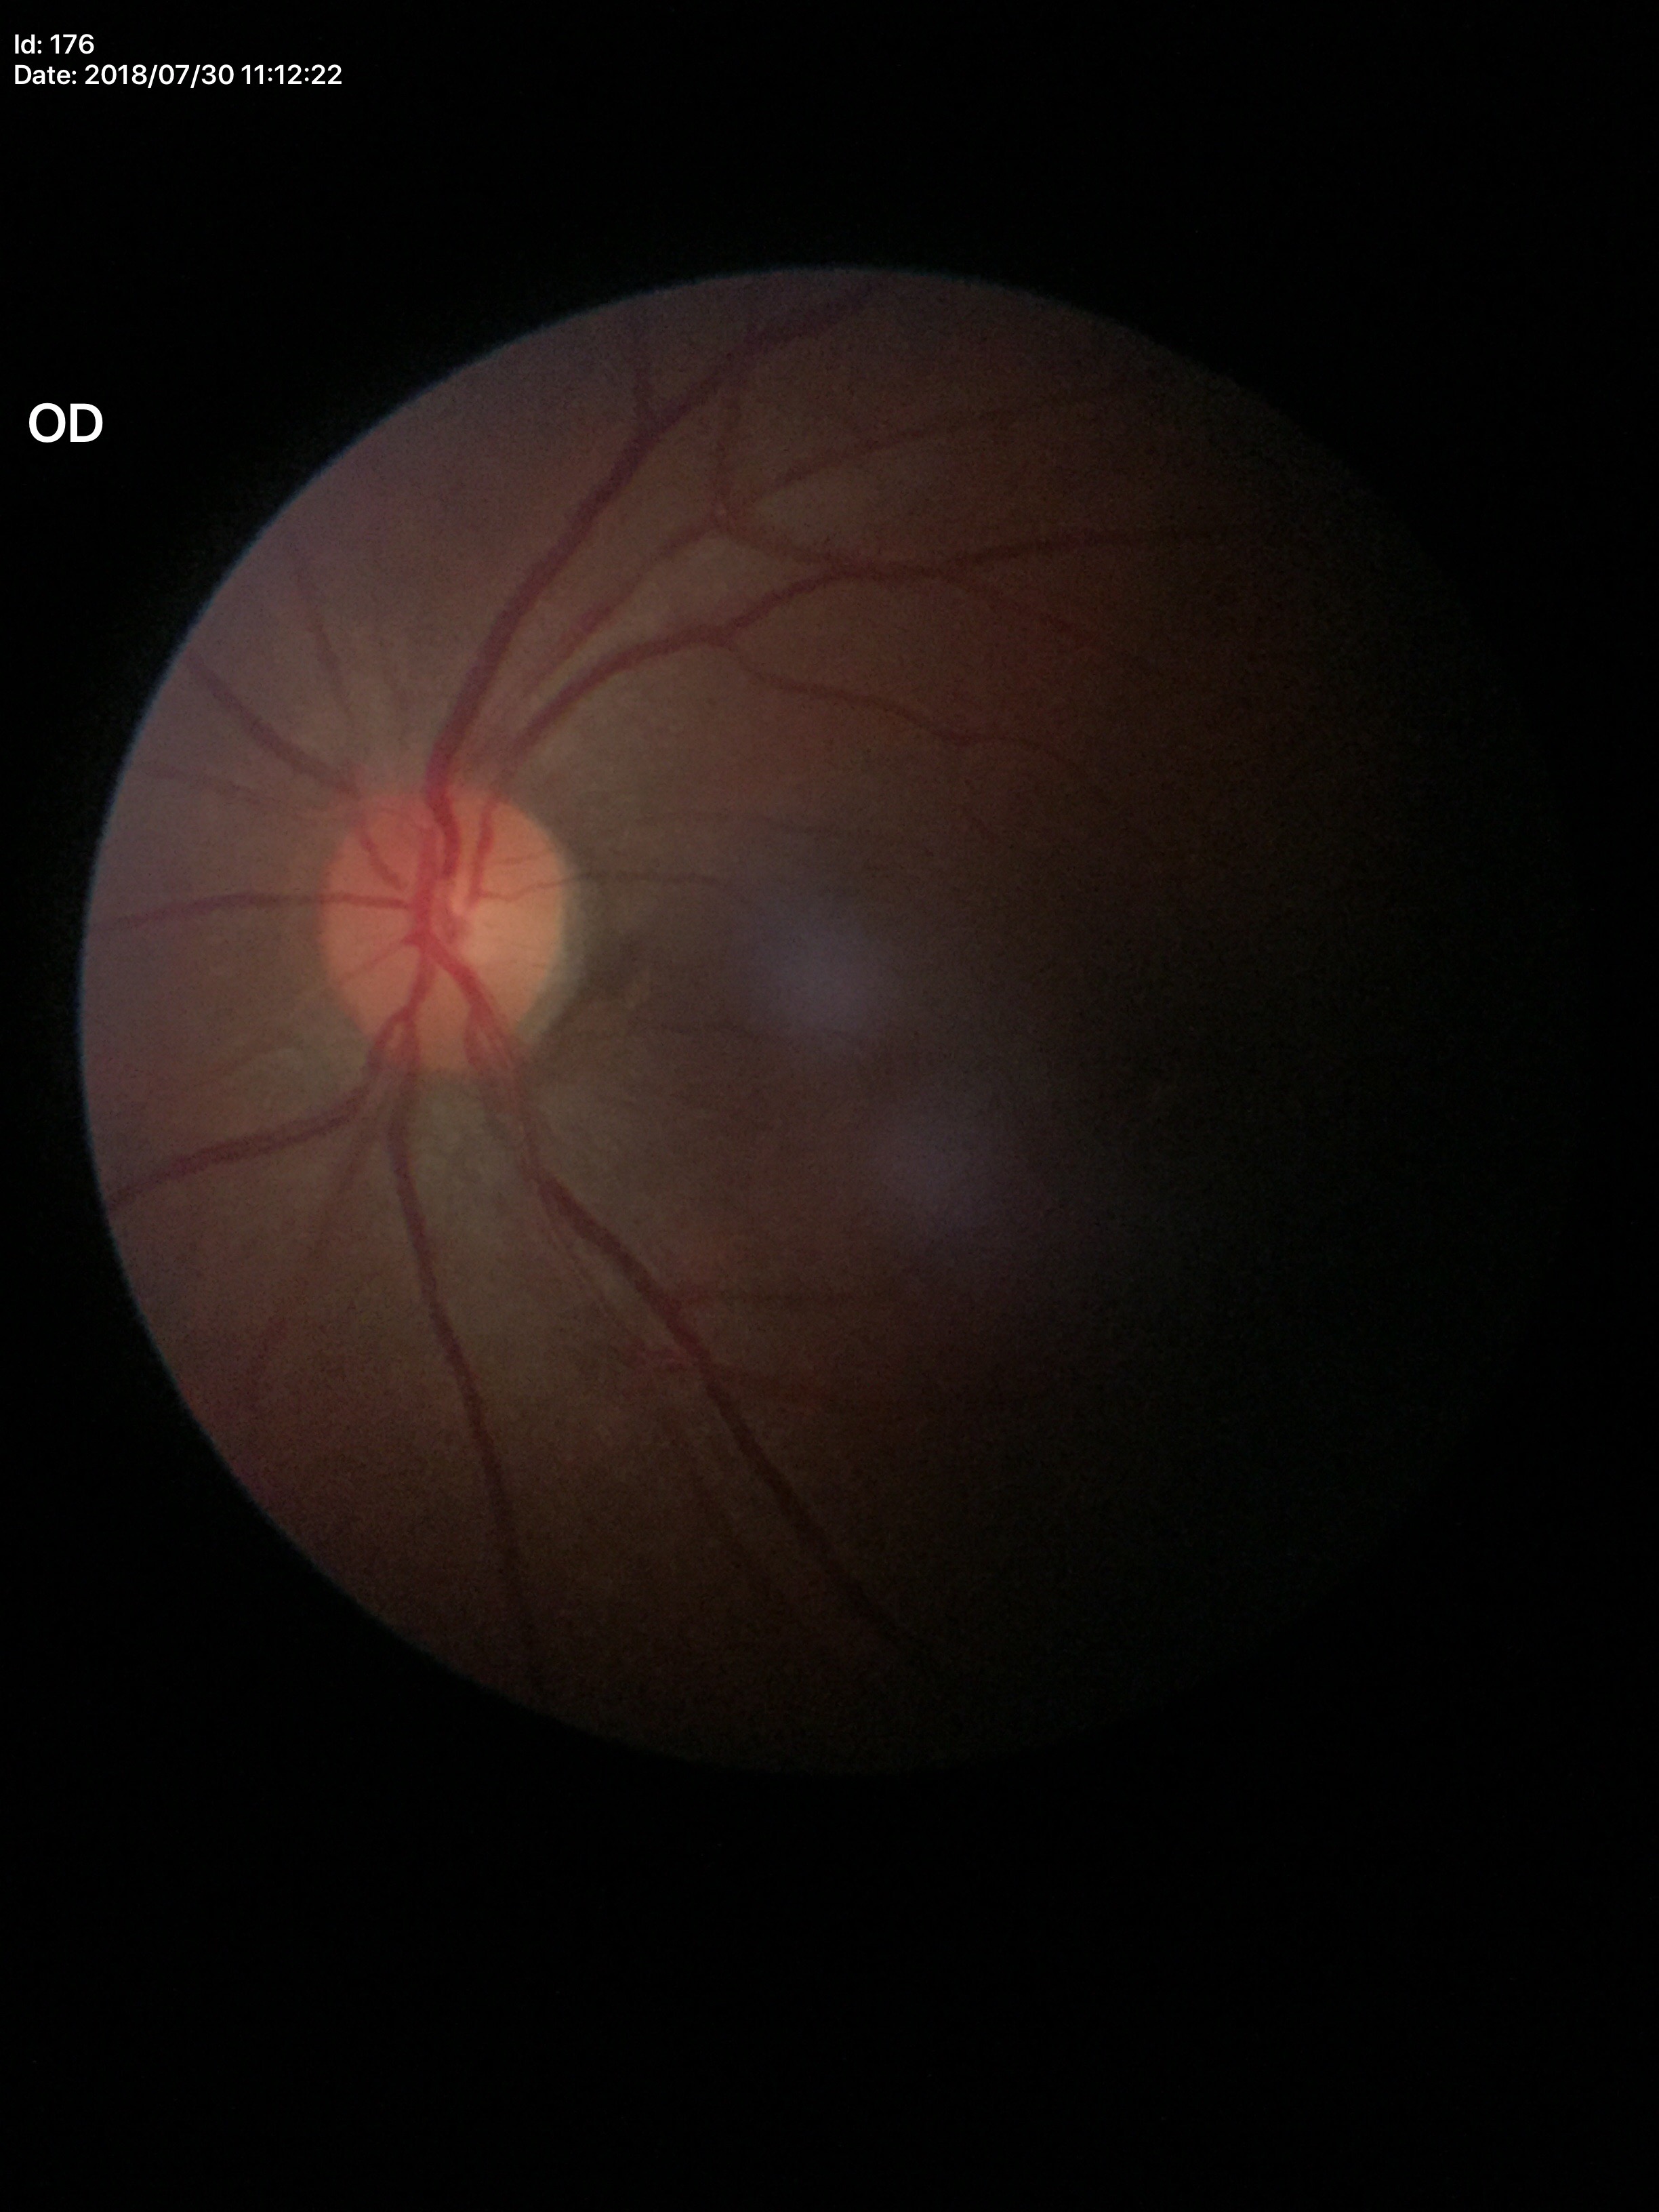 Glaucoma assessment: negative (unanimous normal call), vertical cup-disc ratio: 0.46, horizontal C/D ratio: 0.47.